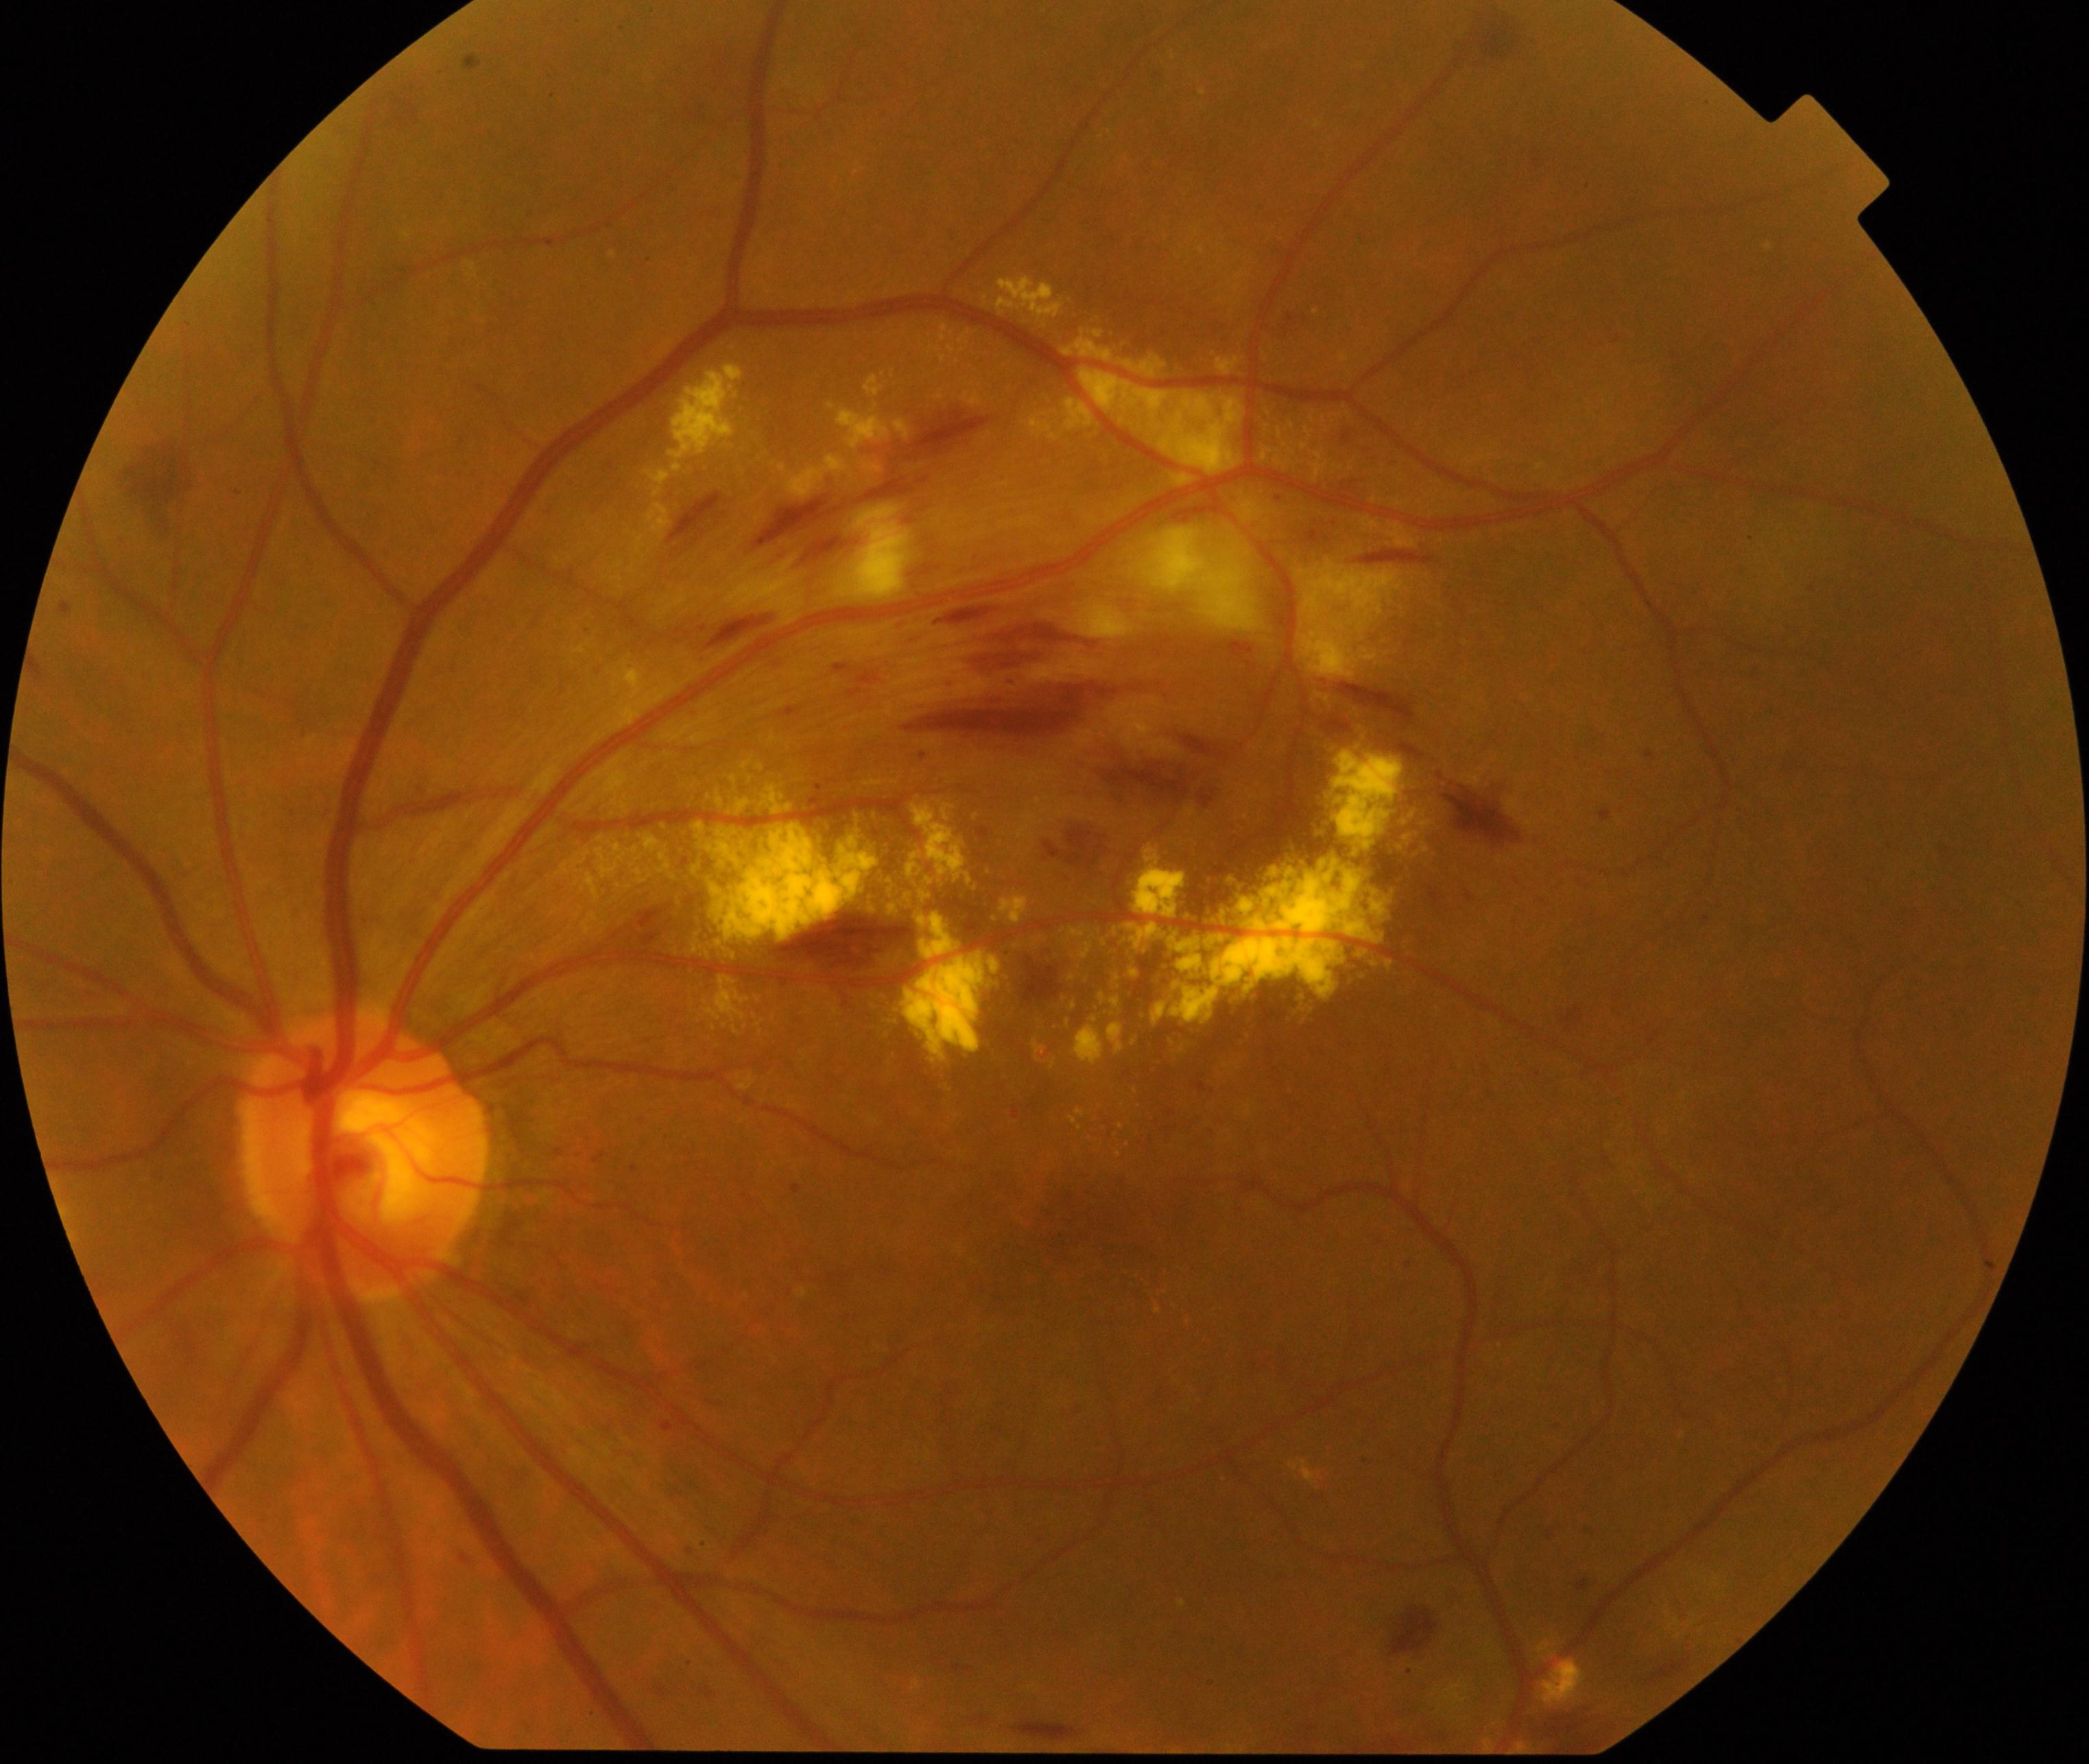
The image shows branch retinal vein occlusion (BRVO).